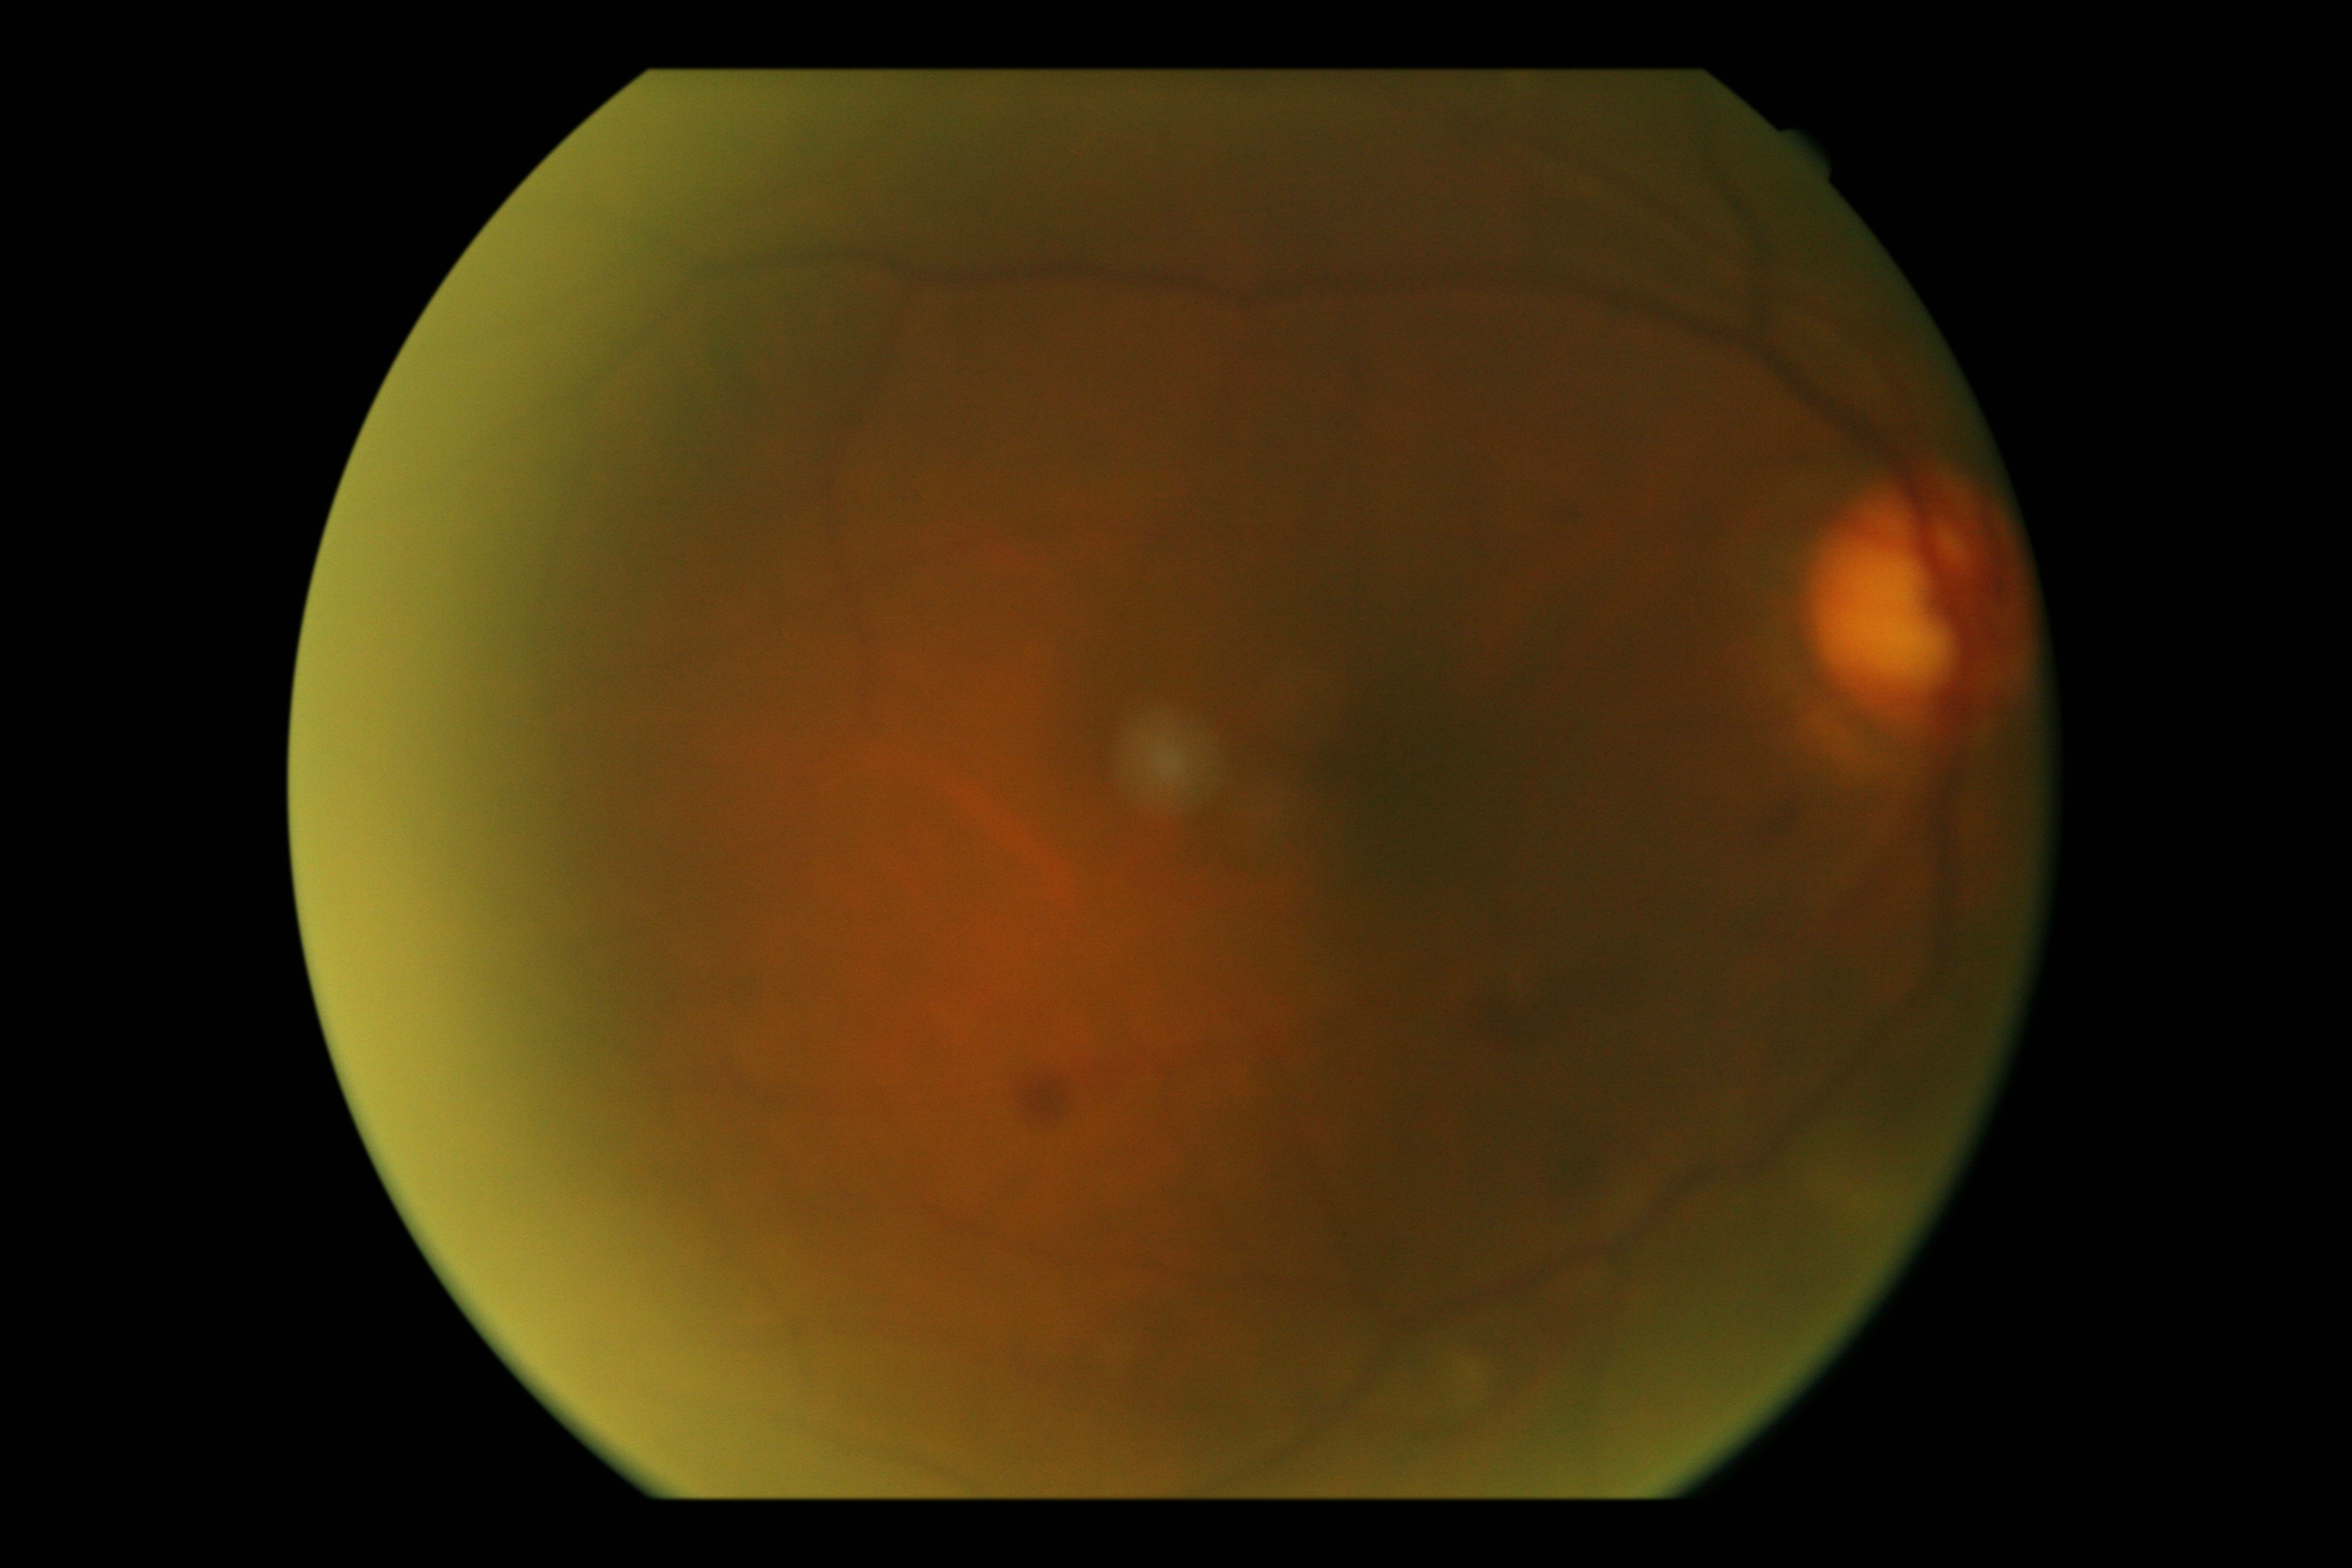 {
  "dr_grade": "moderate non-proliferative diabetic retinopathy (2)"
}